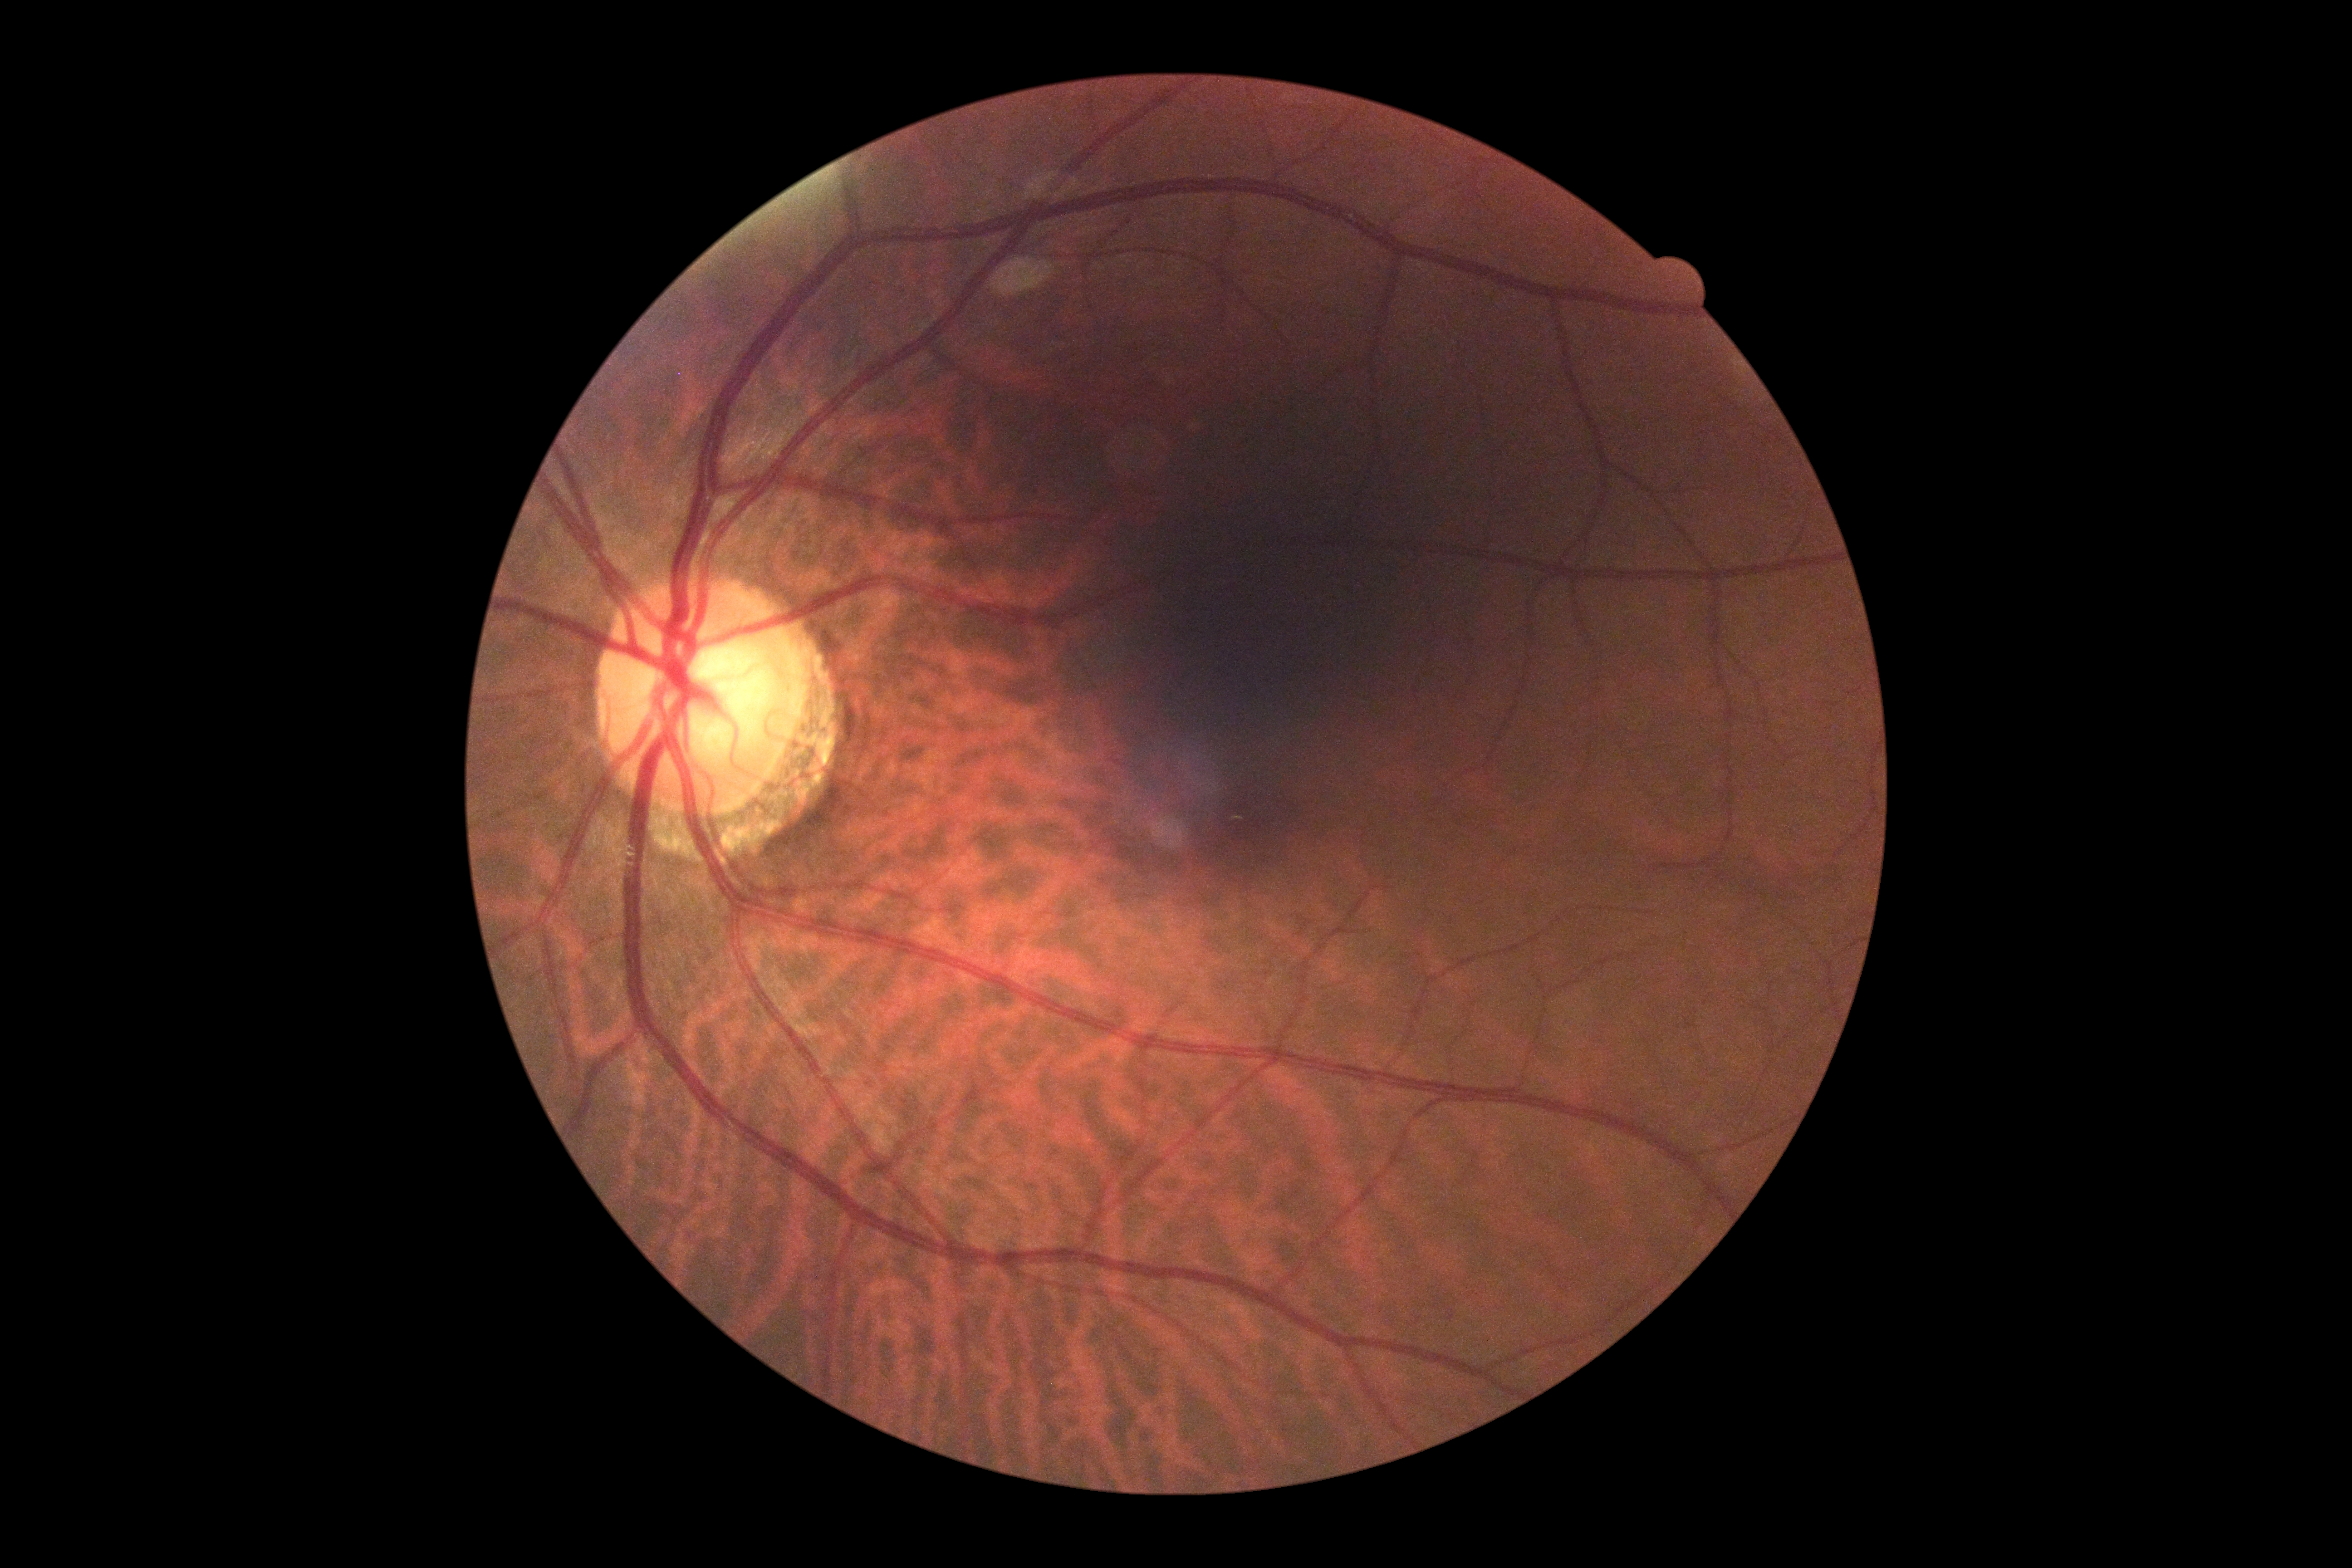

DR severity is no apparent retinopathy (grade 0).